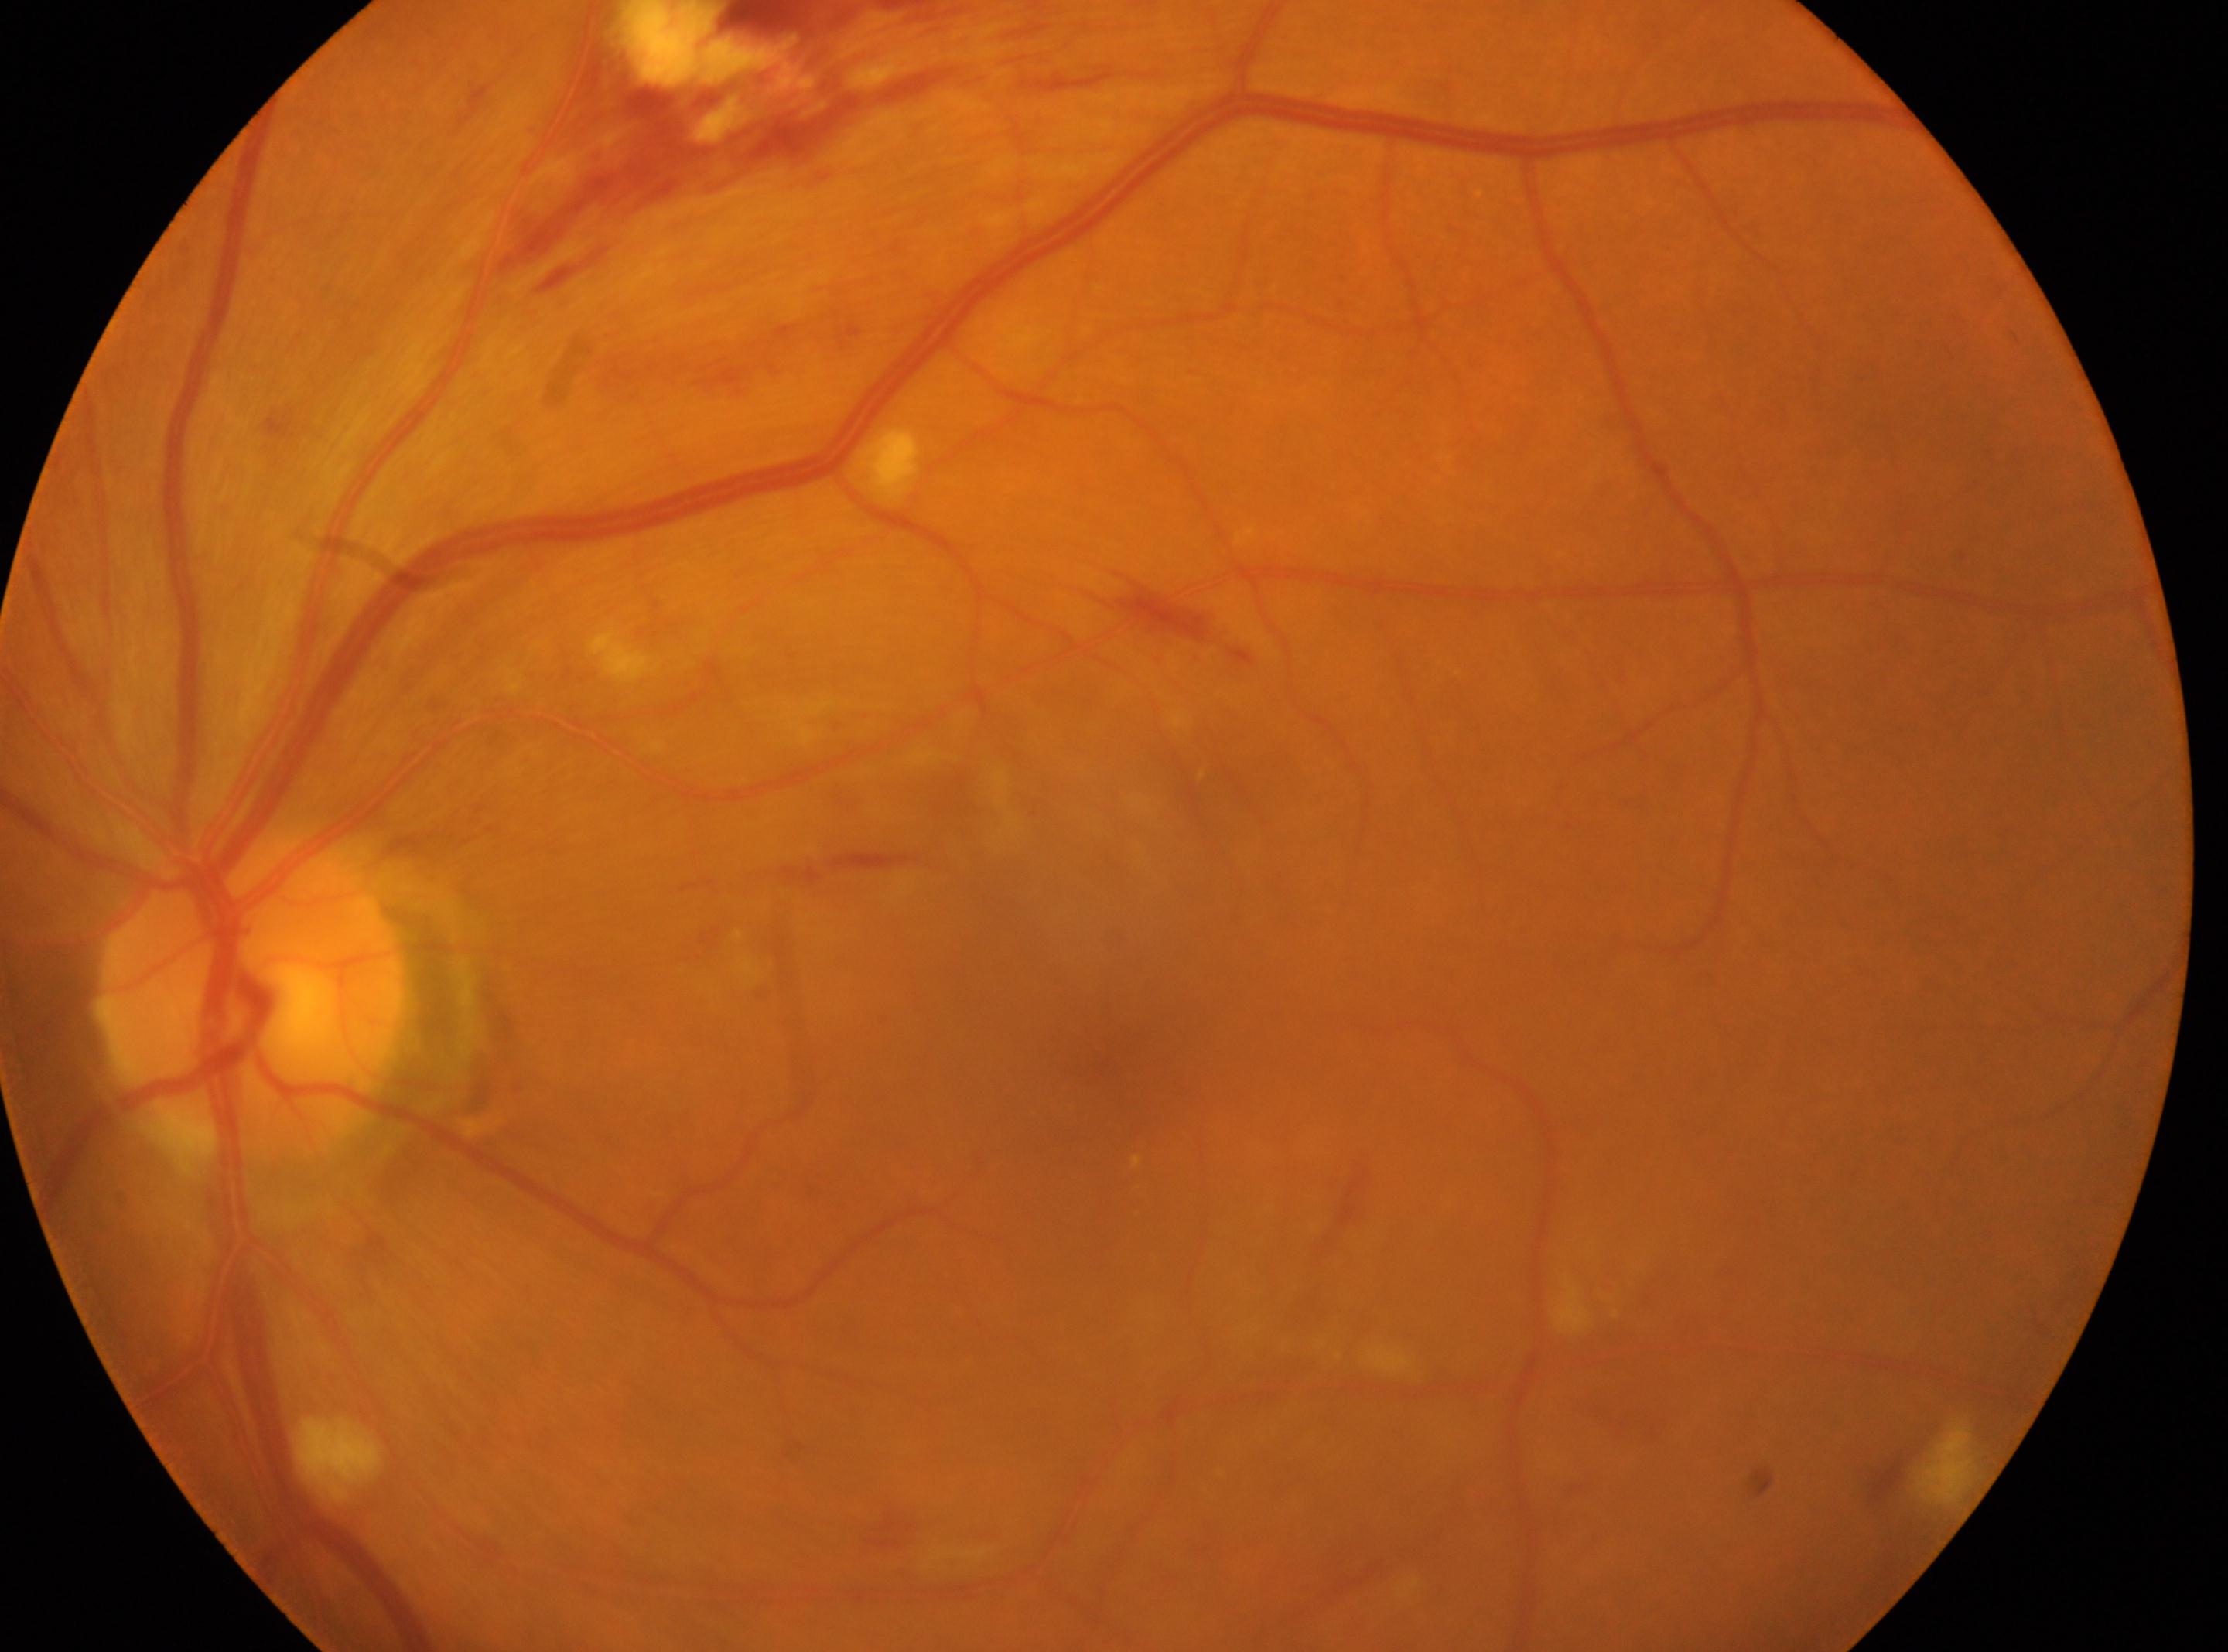

Q: Locate the optic disc.
A: (252, 995)
Q: Right or left eye?
A: left
Q: DR stage?
A: 2/4 — more than just microaneurysms but less than severe NPDR
Q: Where is the fovea?
A: (1114, 1067)